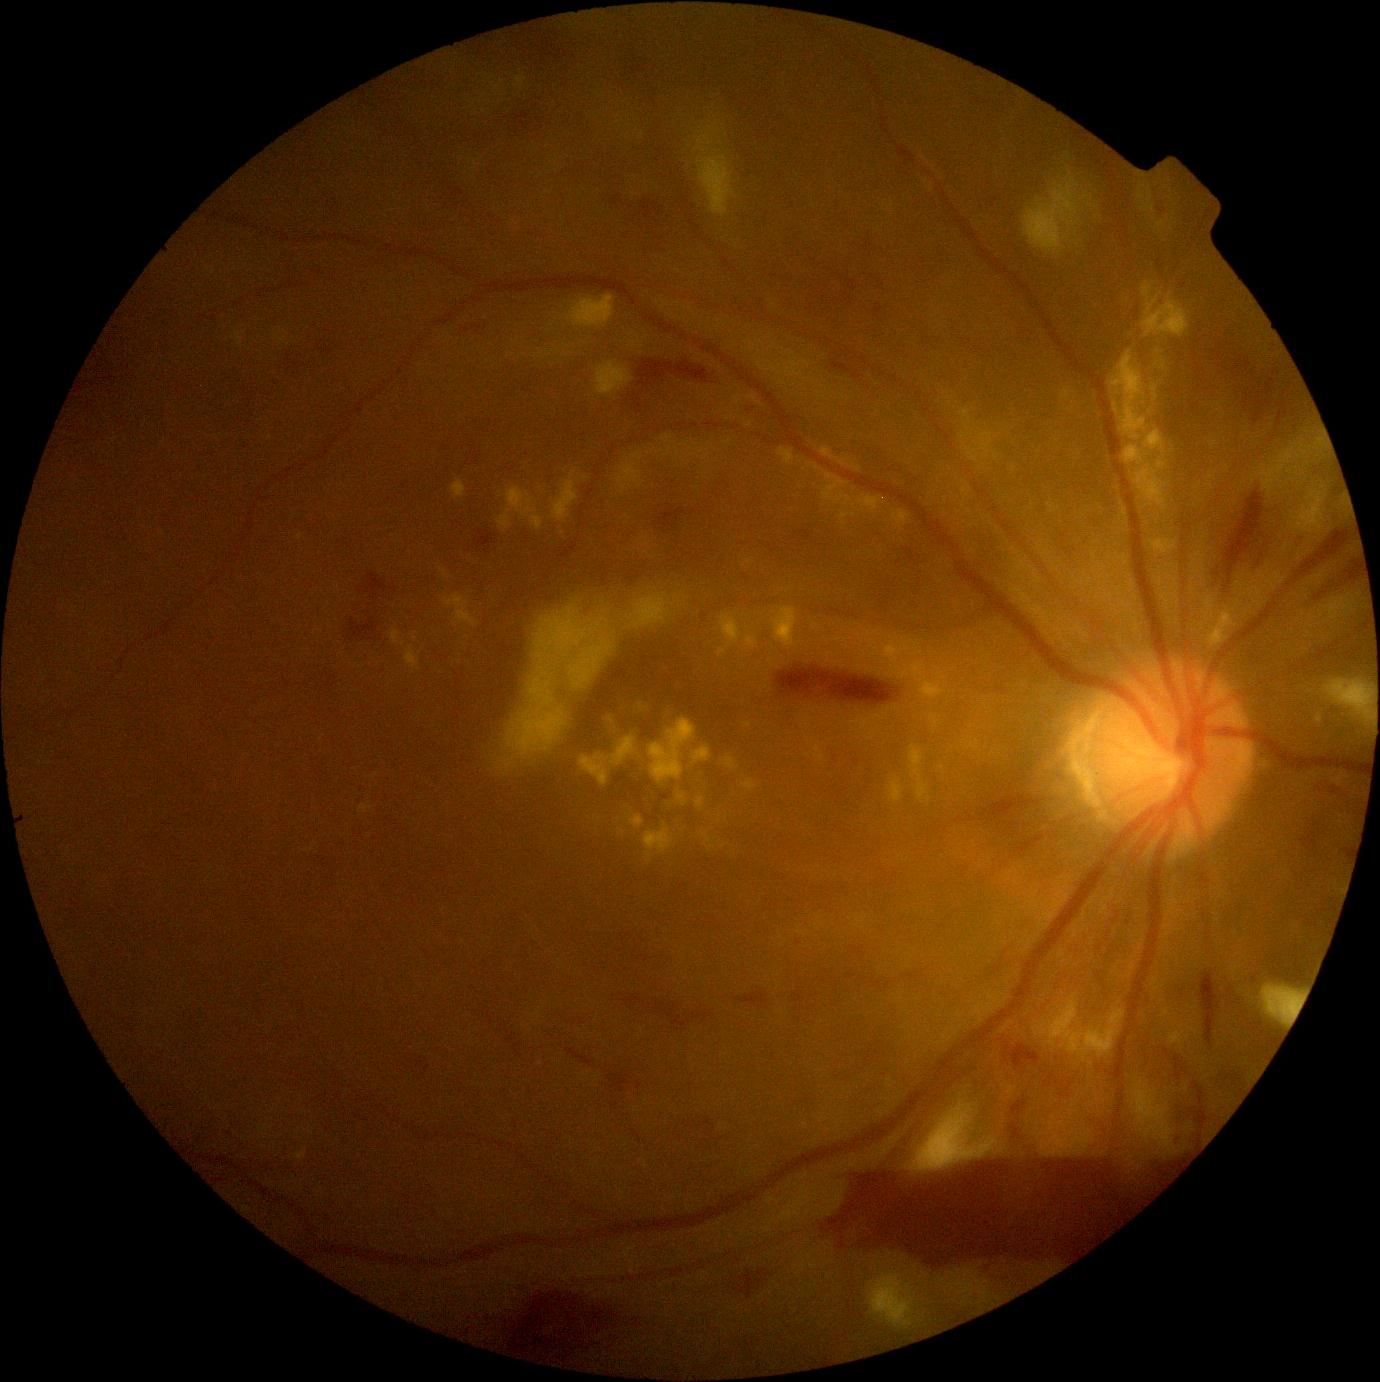
partial: true
dr_grade: 4
dr_grade_name: PDR
lesions:
  ex:
    - Rect(703, 835, 713, 844)
    - Rect(678, 794, 687, 805)
    - Rect(734, 397, 741, 405)
    - Rect(841, 505, 859, 521)
    - Rect(1151, 383, 1159, 402)
    - Rect(889, 779, 904, 804)
    - Rect(884, 637, 923, 670)
    - Rect(644, 824, 675, 860)
    - Rect(389, 630, 401, 645)
    - Rect(651, 719, 696, 783)
    - Rect(580, 755, 609, 786)
    - Rect(691, 746, 712, 766)
  ex_small:
    - <pt>724,847</pt>
    - <pt>712,849</pt>
    - <pt>1170,296</pt>
    - <pt>753,399</pt>
    - <pt>1151,411</pt>
    - <pt>997,456</pt>